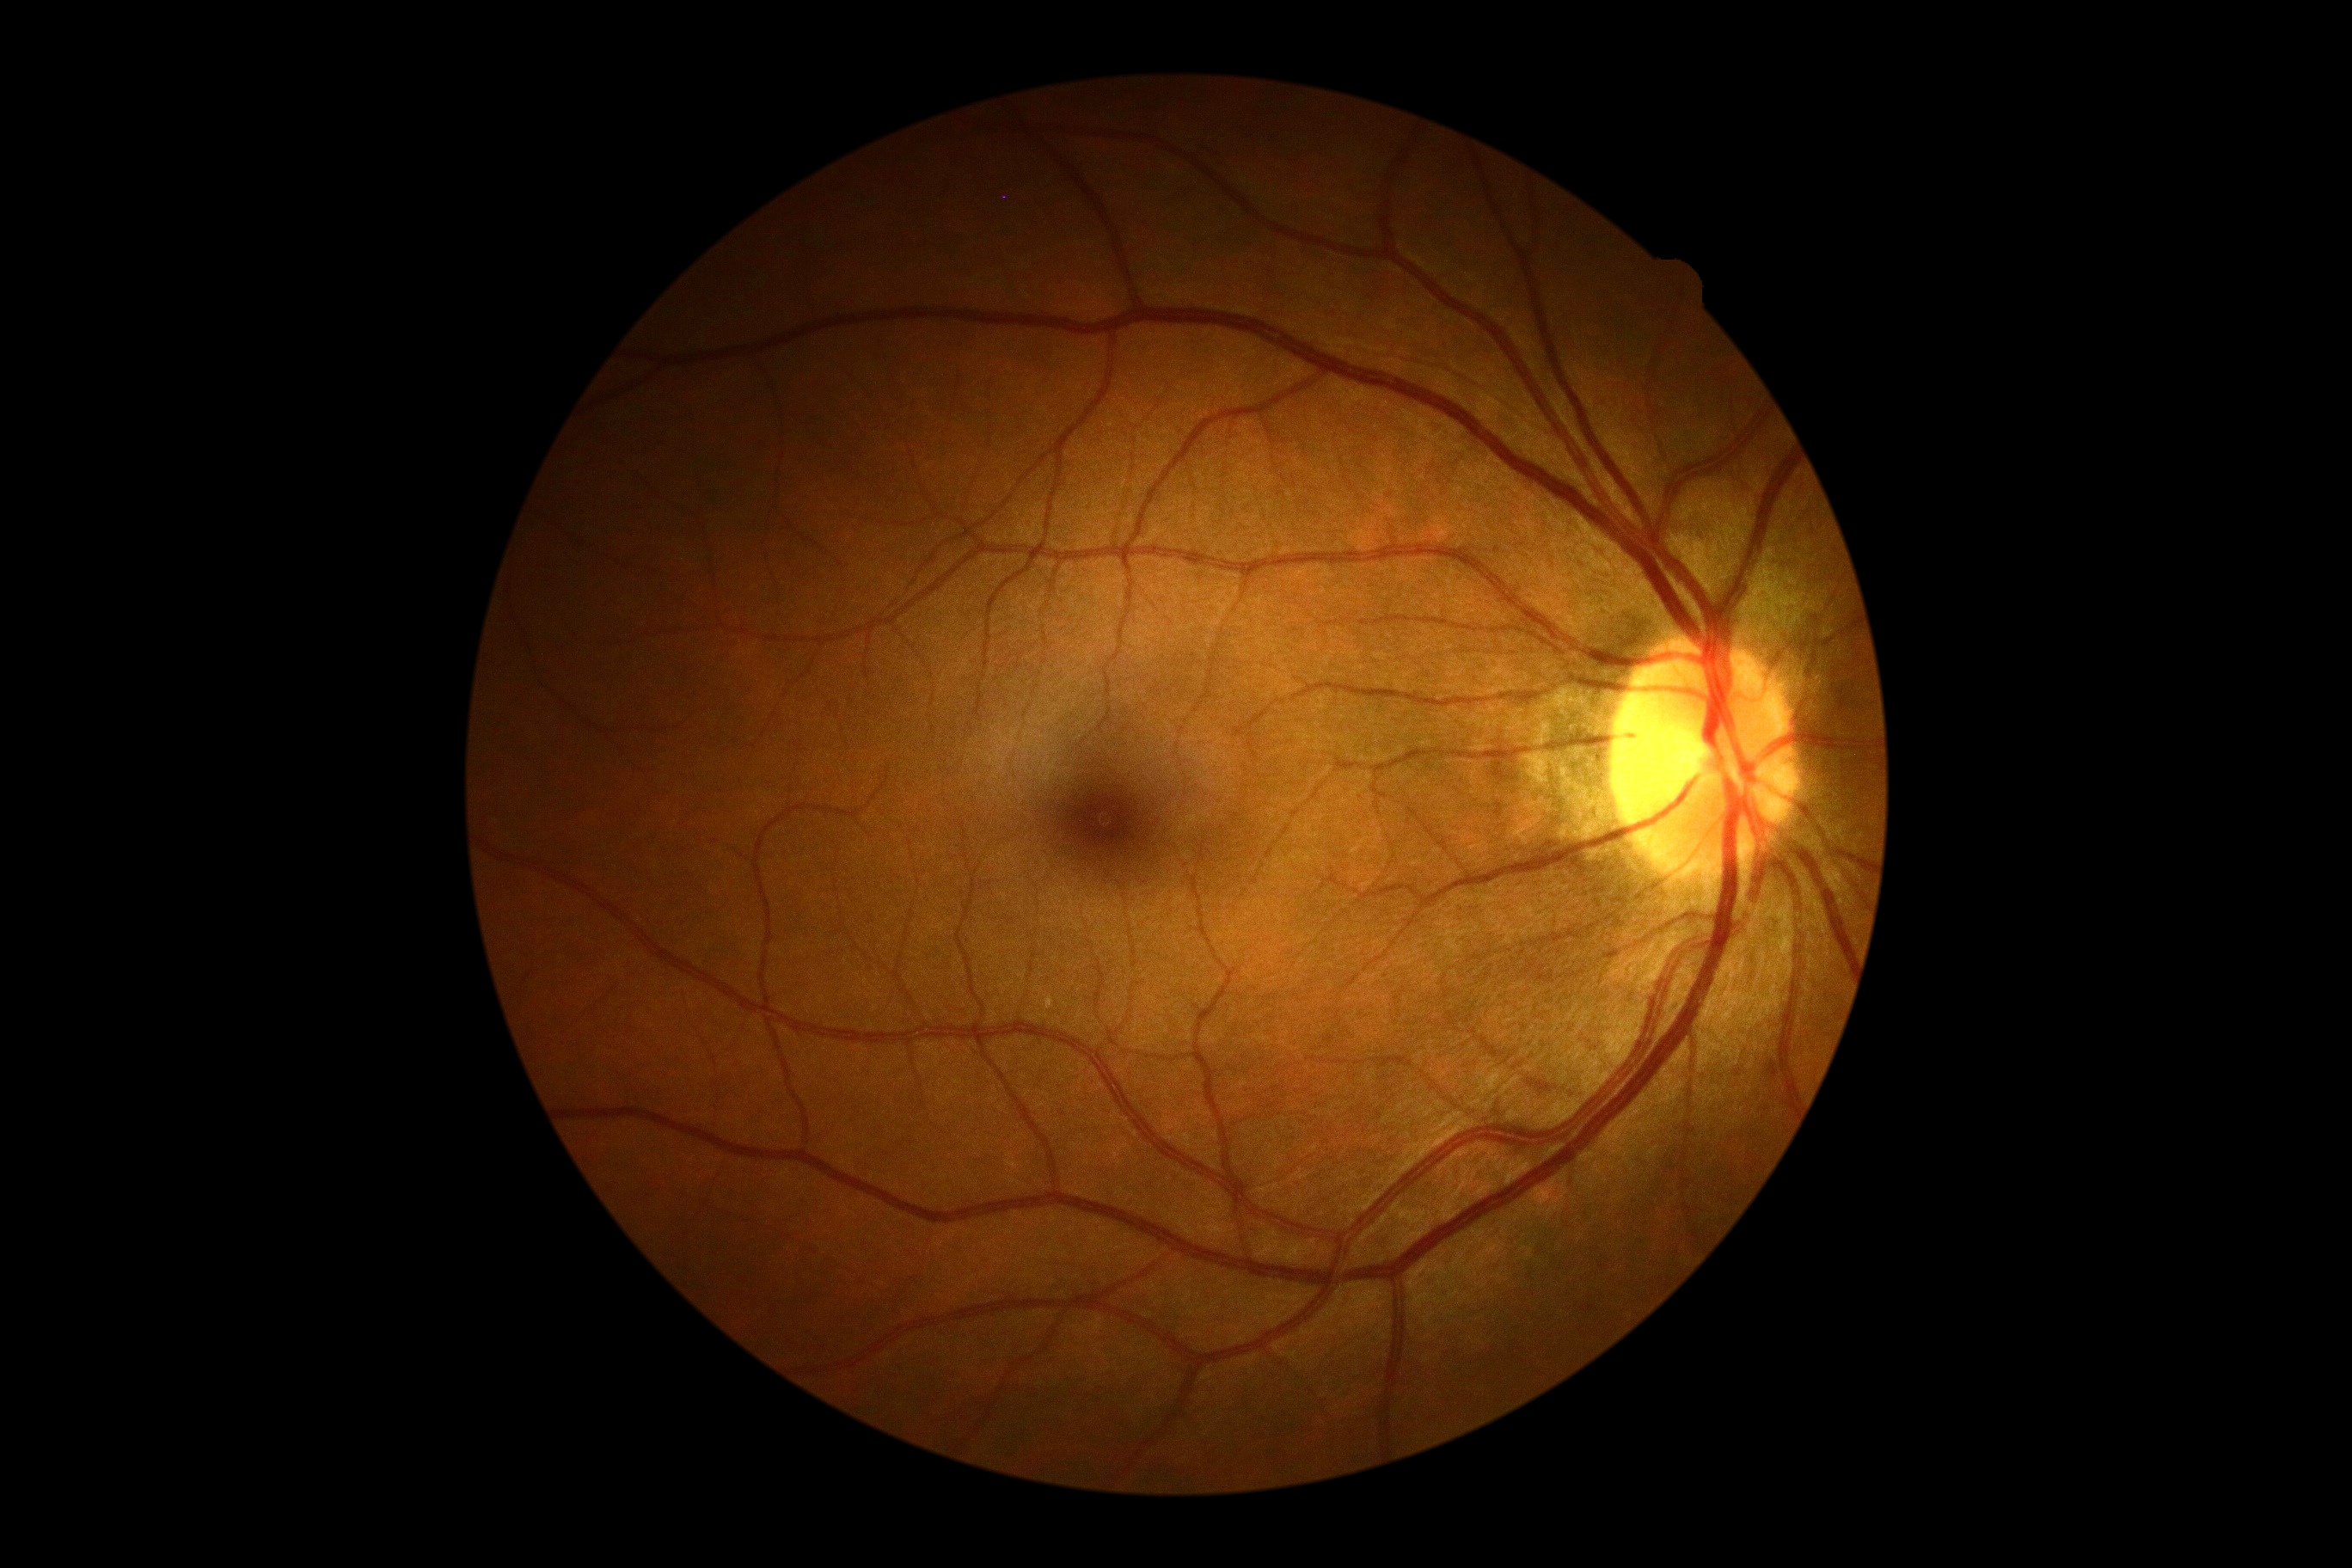
Retinopathy: grade 0.